Fundus photo
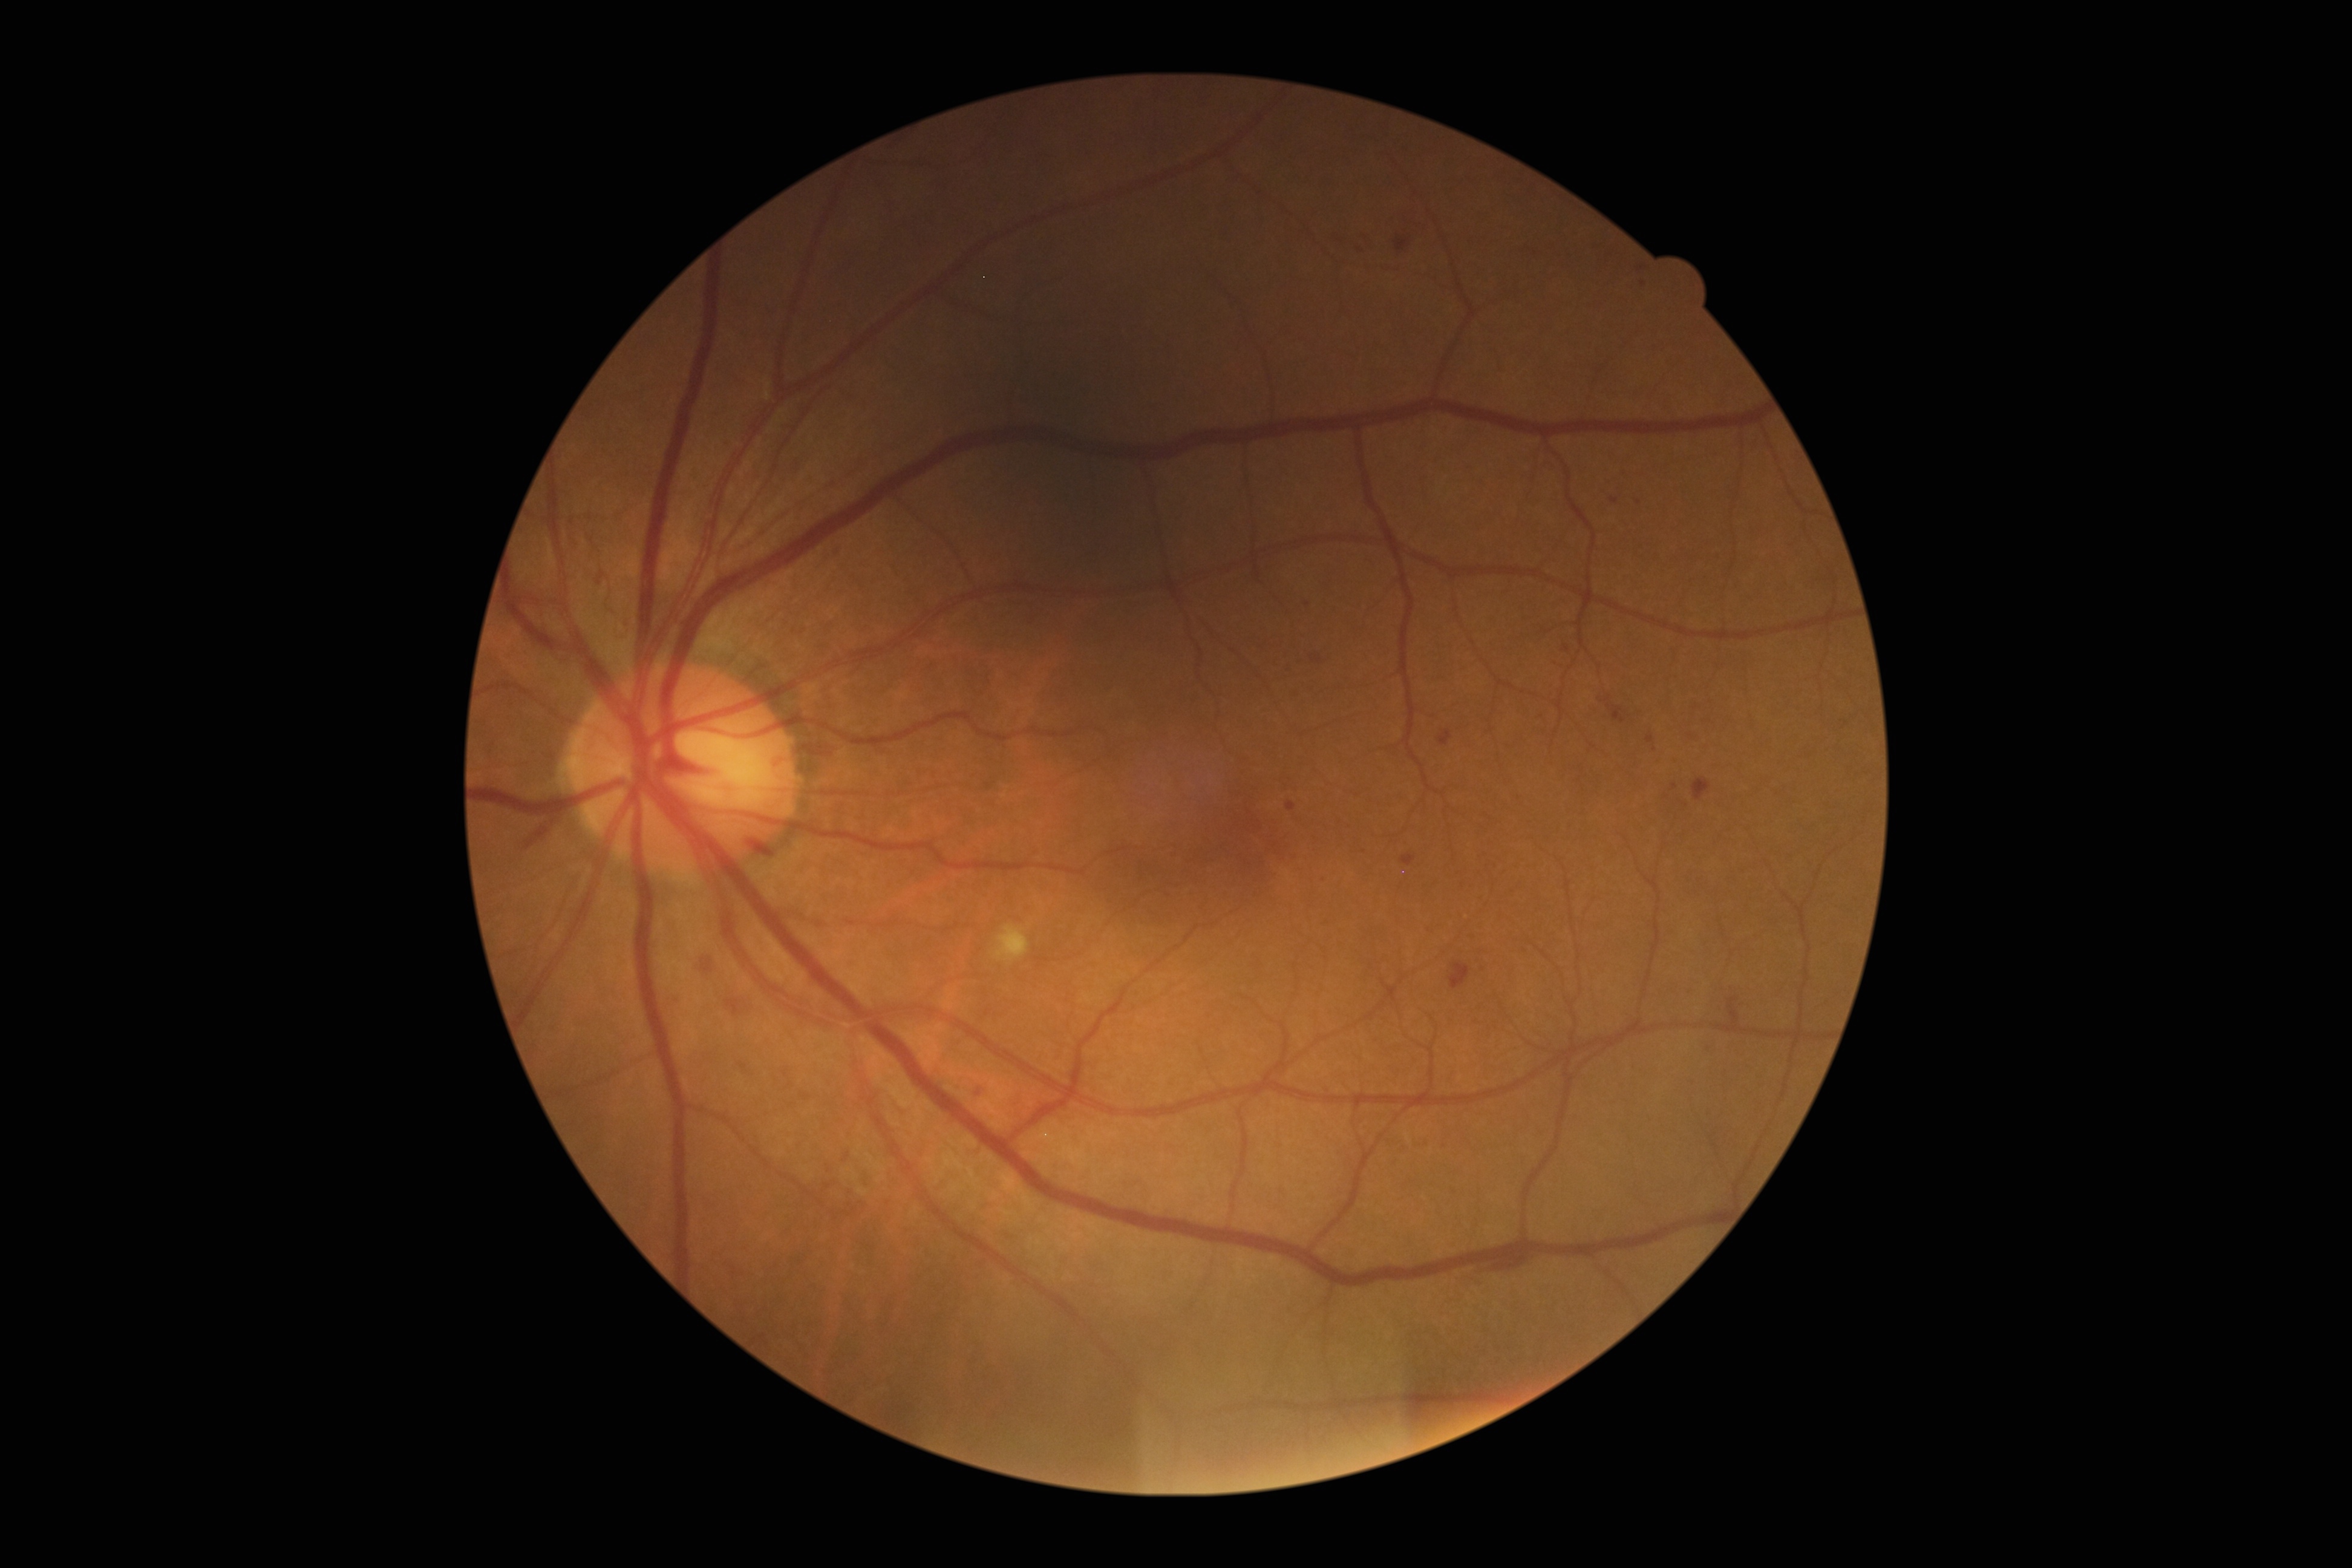

DR stage is 2/4 — more than just microaneurysms but less than severe NPDR
Lesions identified (partial list):
* HEs: [x1=1727, y1=996, x2=1740, y2=1023], [x1=724, y1=999, x2=743, y2=1017], [x1=701, y1=959, x2=713, y2=972], [x1=739, y1=1062, x2=748, y2=1070], [x1=521, y1=814, x2=555, y2=849], [x1=1394, y1=238, x2=1410, y2=251], [x1=1606, y1=704, x2=1625, y2=723], [x1=1449, y1=962, x2=1471, y2=989], [x1=1491, y1=1250, x2=1530, y2=1272], [x1=1693, y1=777, x2=1710, y2=802], [x1=747, y1=841, x2=774, y2=852]
* EXs: none detected
* MAs (partial): [x1=1285, y1=802, x2=1295, y2=811], [x1=783, y1=1071, x2=788, y2=1079], [x1=592, y1=572, x2=599, y2=581], [x1=1561, y1=645, x2=1570, y2=653], [x1=1439, y1=730, x2=1452, y2=746], [x1=802, y1=1093, x2=810, y2=1100], [x1=844, y1=1152, x2=850, y2=1161], [x1=1525, y1=944, x2=1530, y2=955]
* MAs (small, approximate centers) near [1308,604], [1364,240], [1360,249], [790,1084]
* SEs: [x1=995, y1=925, x2=1029, y2=961]